NIDEK AFC-230 fundus camera
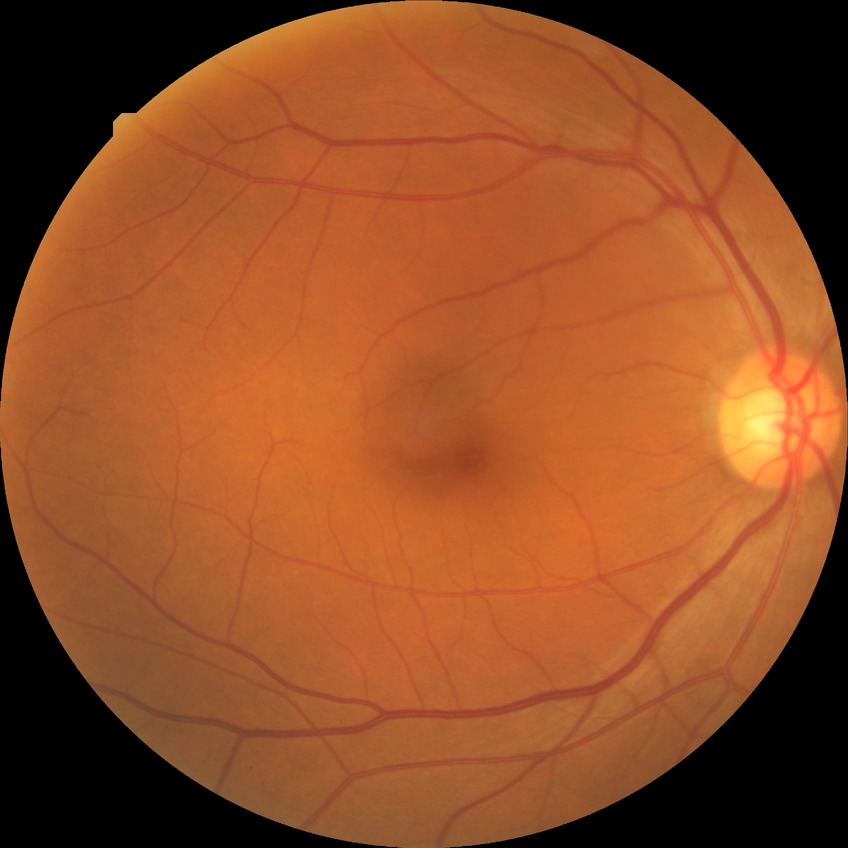

DR stage: NDR.